240x240. Cropped to the optic nerve head.
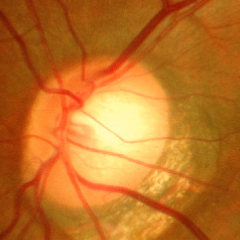
Assessment: advanced glaucoma.